Retinal fundus photograph, 45-degree field of view.
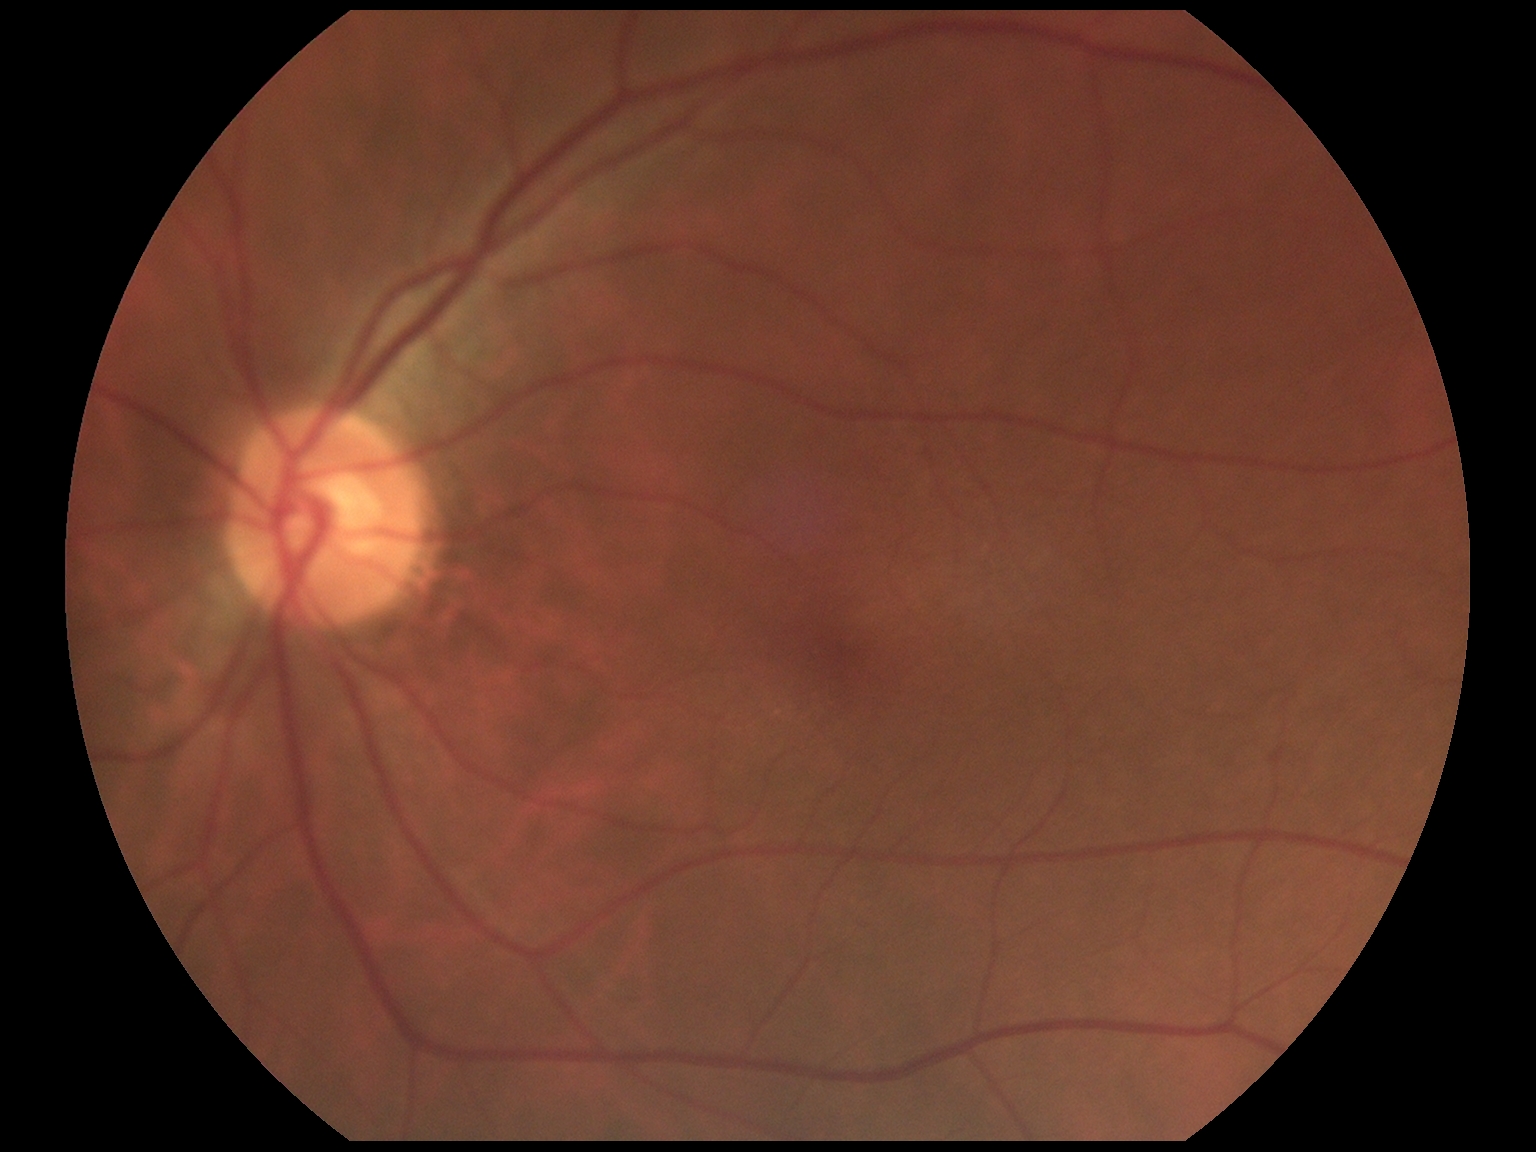

DR: no apparent retinopathy (grade 0).